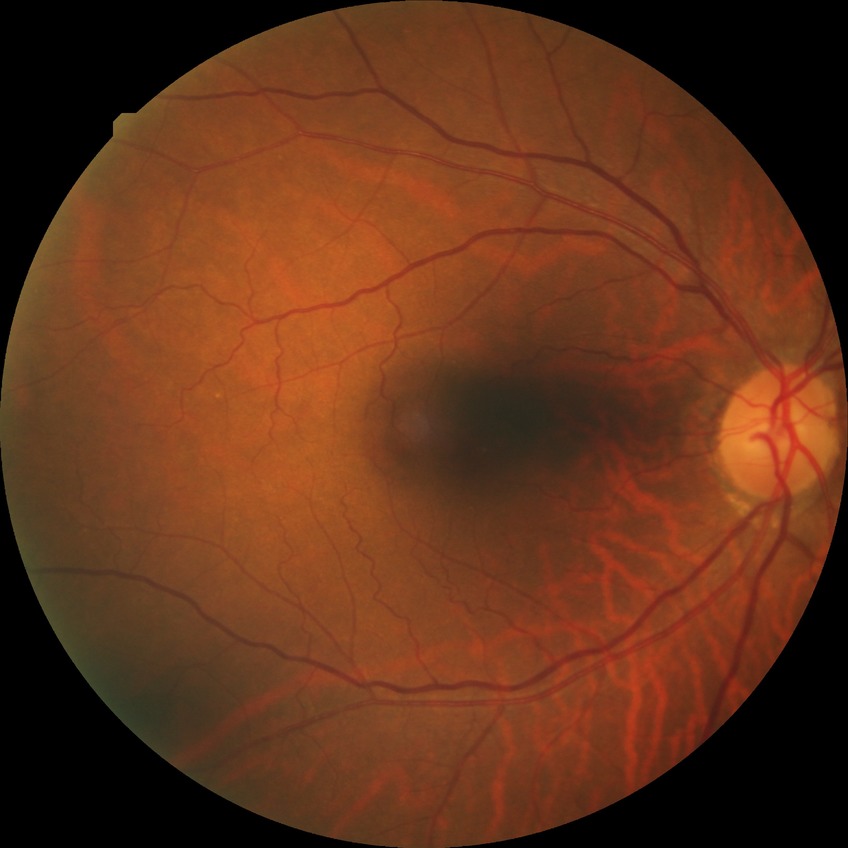
DR grade = NDR.